Image size 640x480; Clarity RetCam 3, 130° FOV; wide-field fundus photograph of an infant: 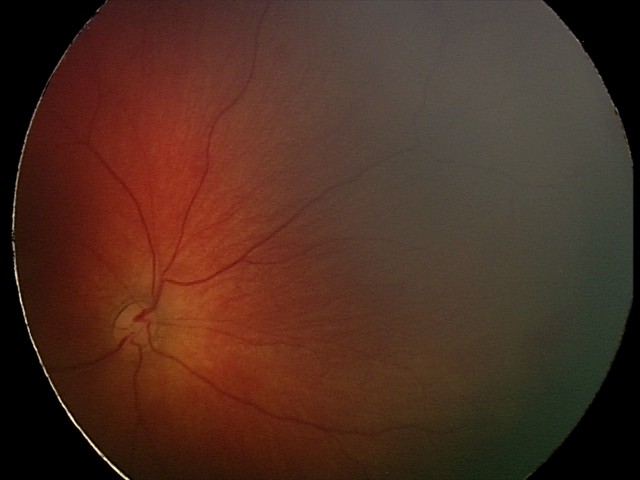 From an examination with diagnosis of retinal hemorrhages.